Davis DR grading. FOV: 45 degrees. 848x848px — 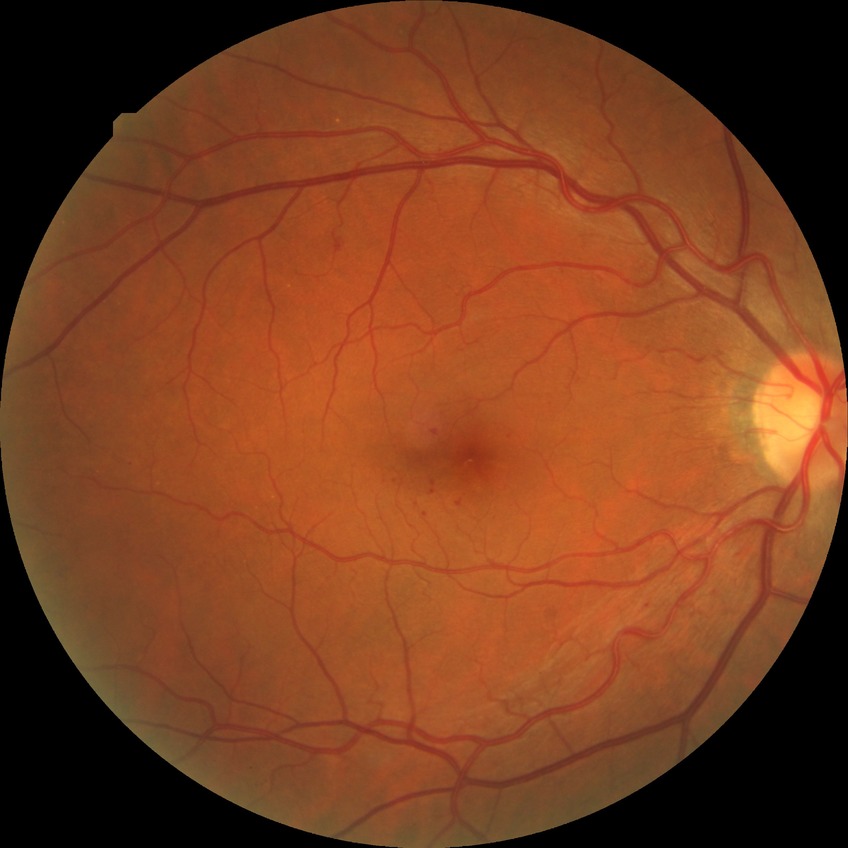
Diabetic retinopathy stage is simple diabetic retinopathy.
The retinopathy is classified as non-proliferative diabetic retinopathy.